Wide-field fundus image from infant ROP screening:
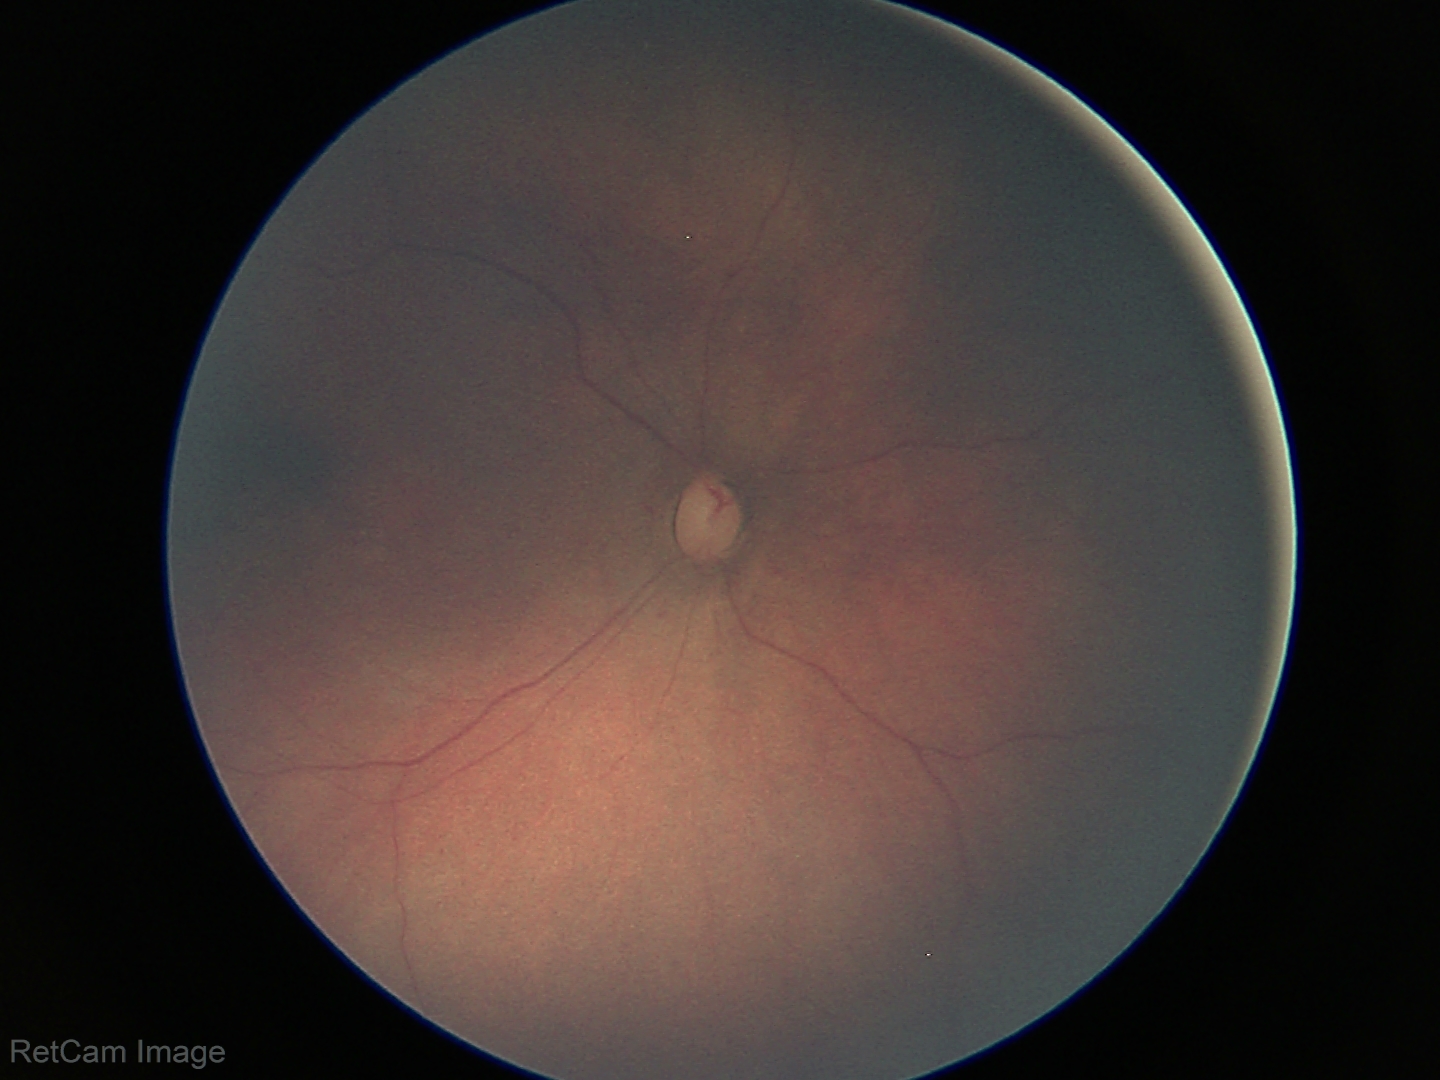 Screening examination with no abnormal retinal findings.